Wide-field contact fundus photograph of an infant — 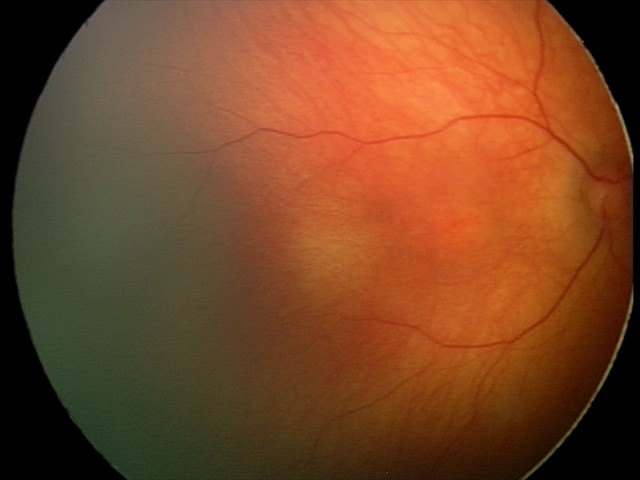 Examination with physiological retinal findings.